Wide-field fundus photograph of an infant — 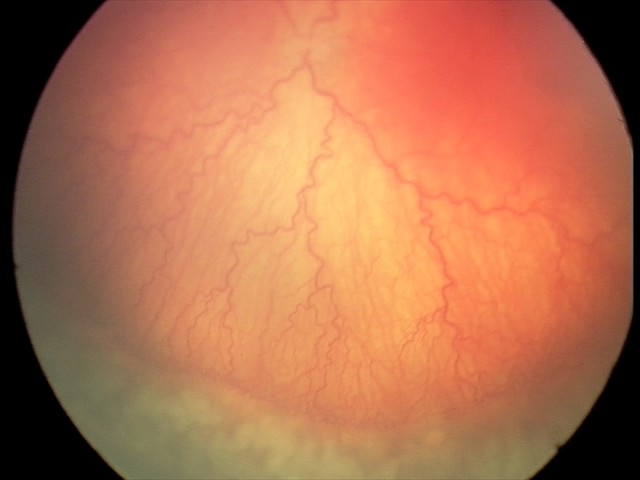

Assessment: aggressive ROP (A-ROP) — rapidly progressive severe ROP with prominent plus disease, often without classic stage progression | plus disease.